Color fundus image, FOV: 45 degrees.
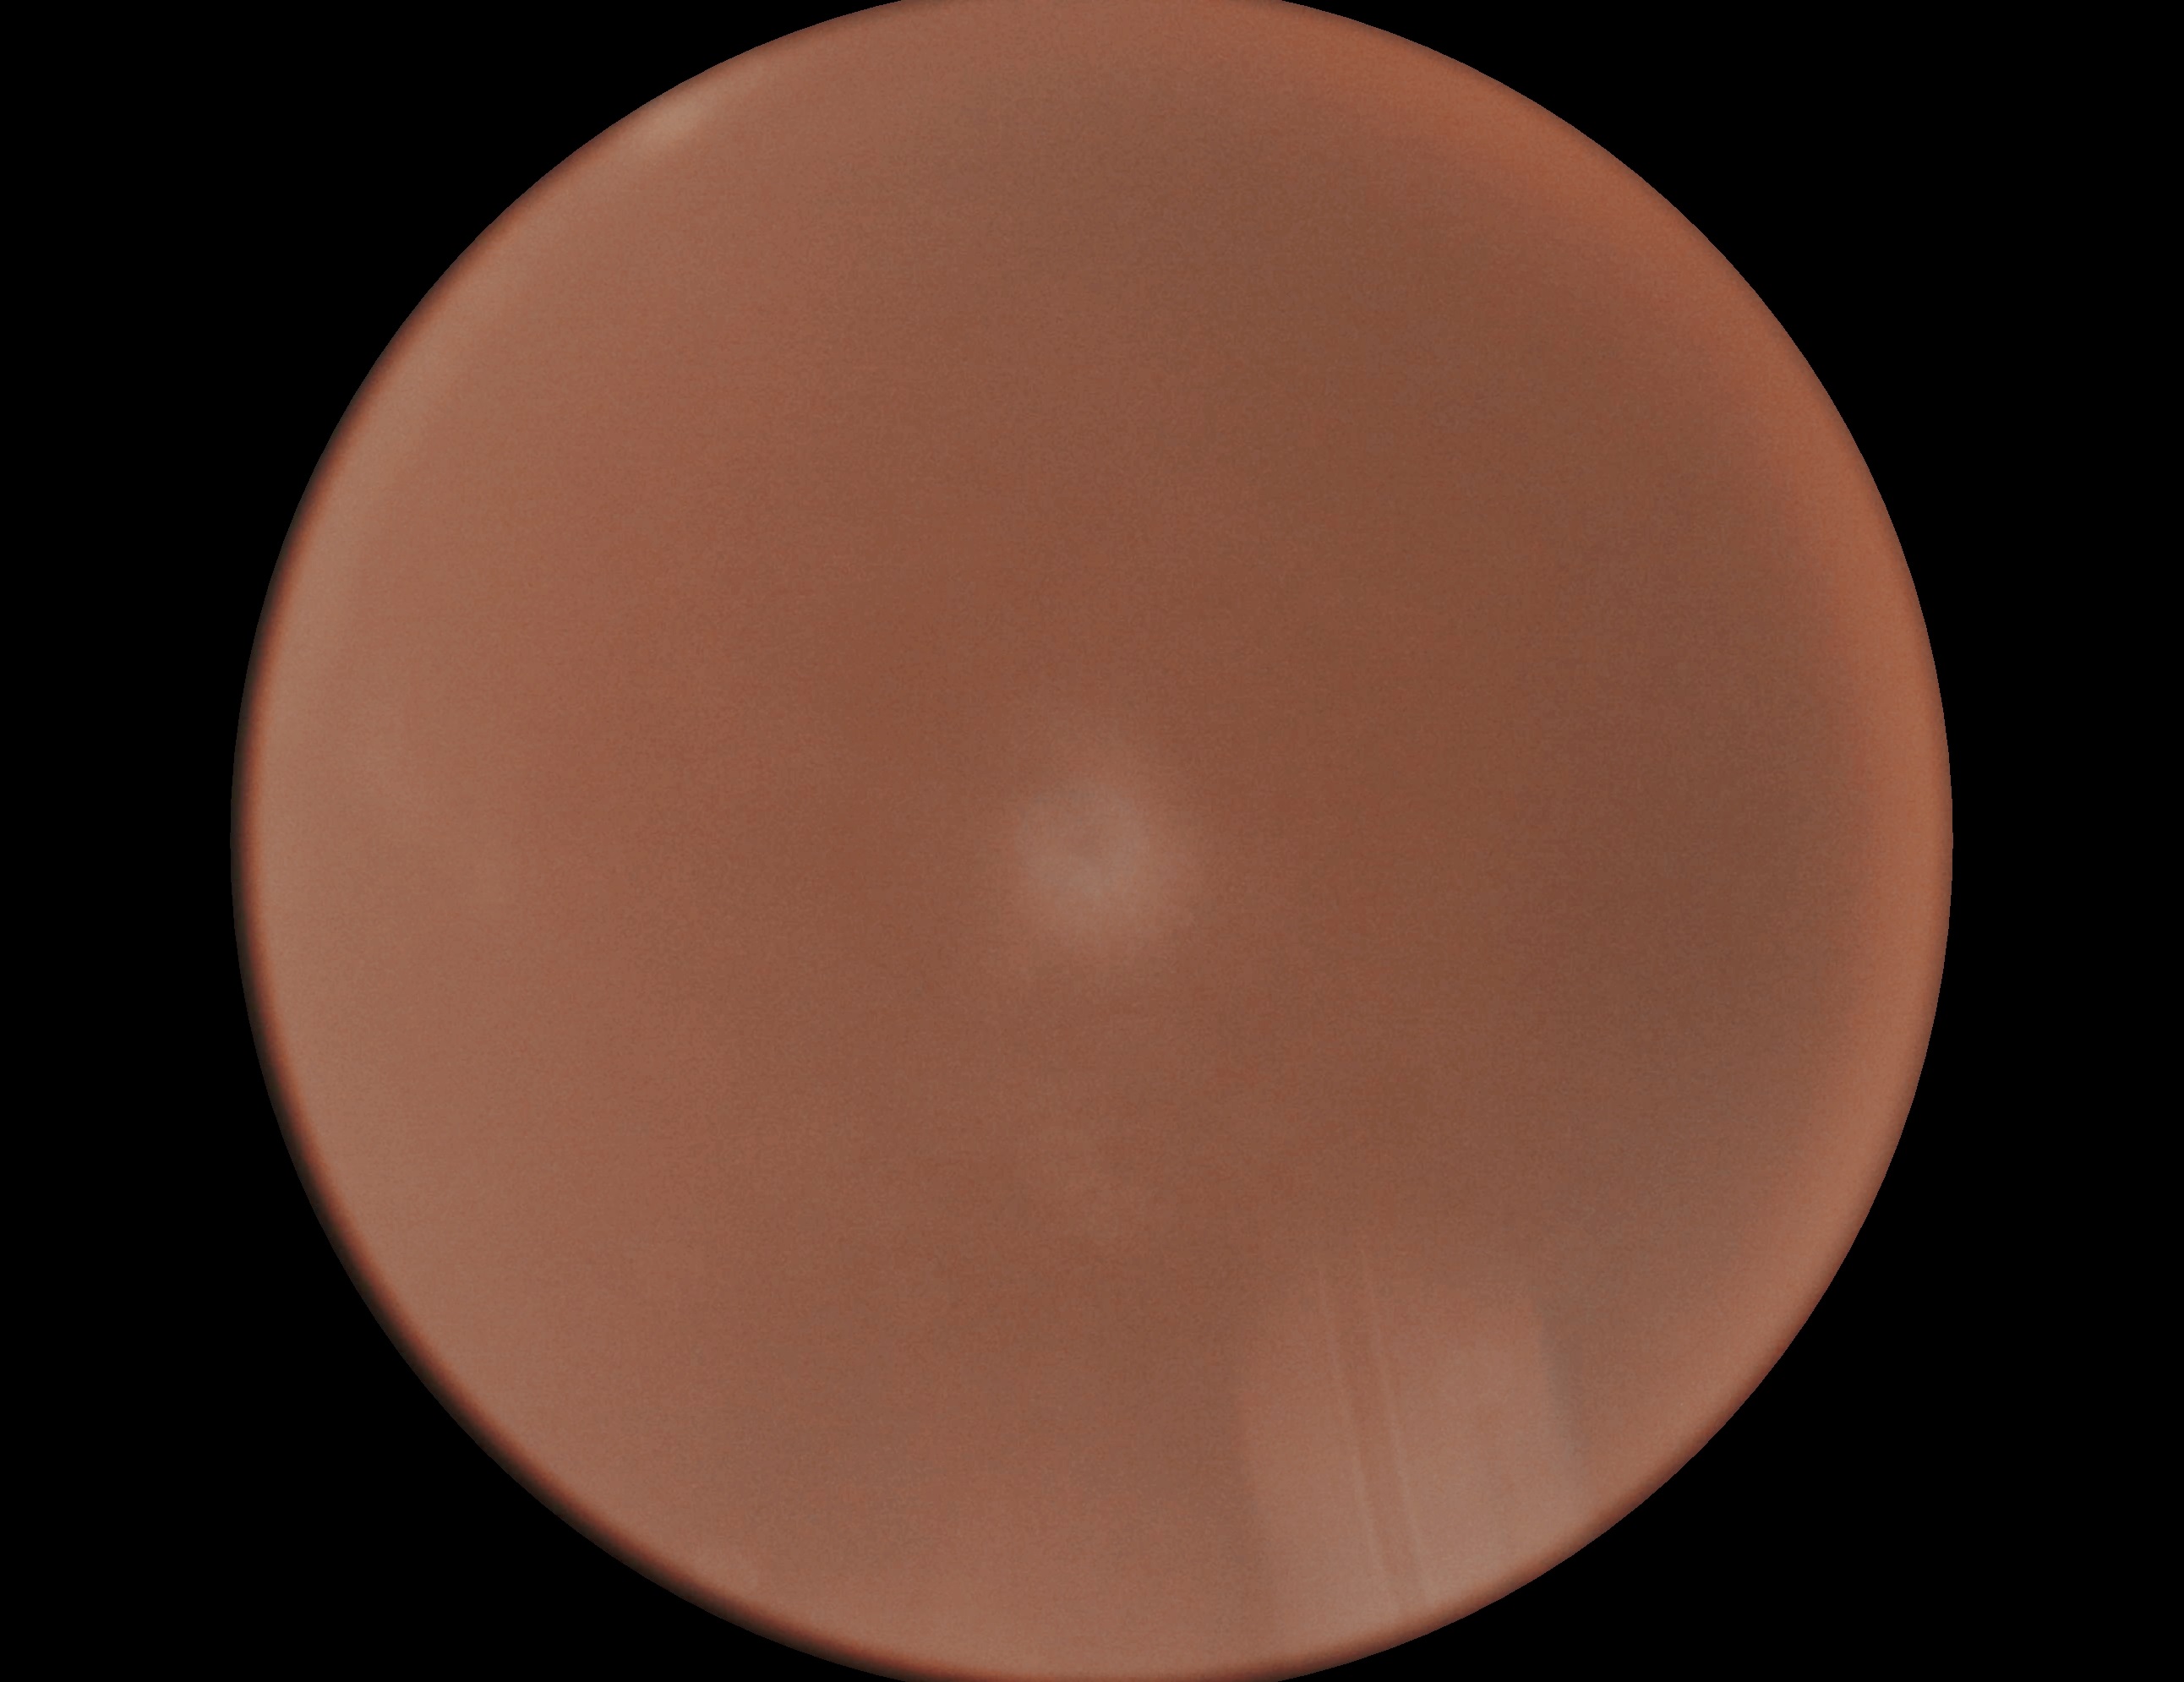
Diabetic retinopathy severity is ungradable.